45° field of view. Color fundus photograph. 2048 x 1536 pixels.
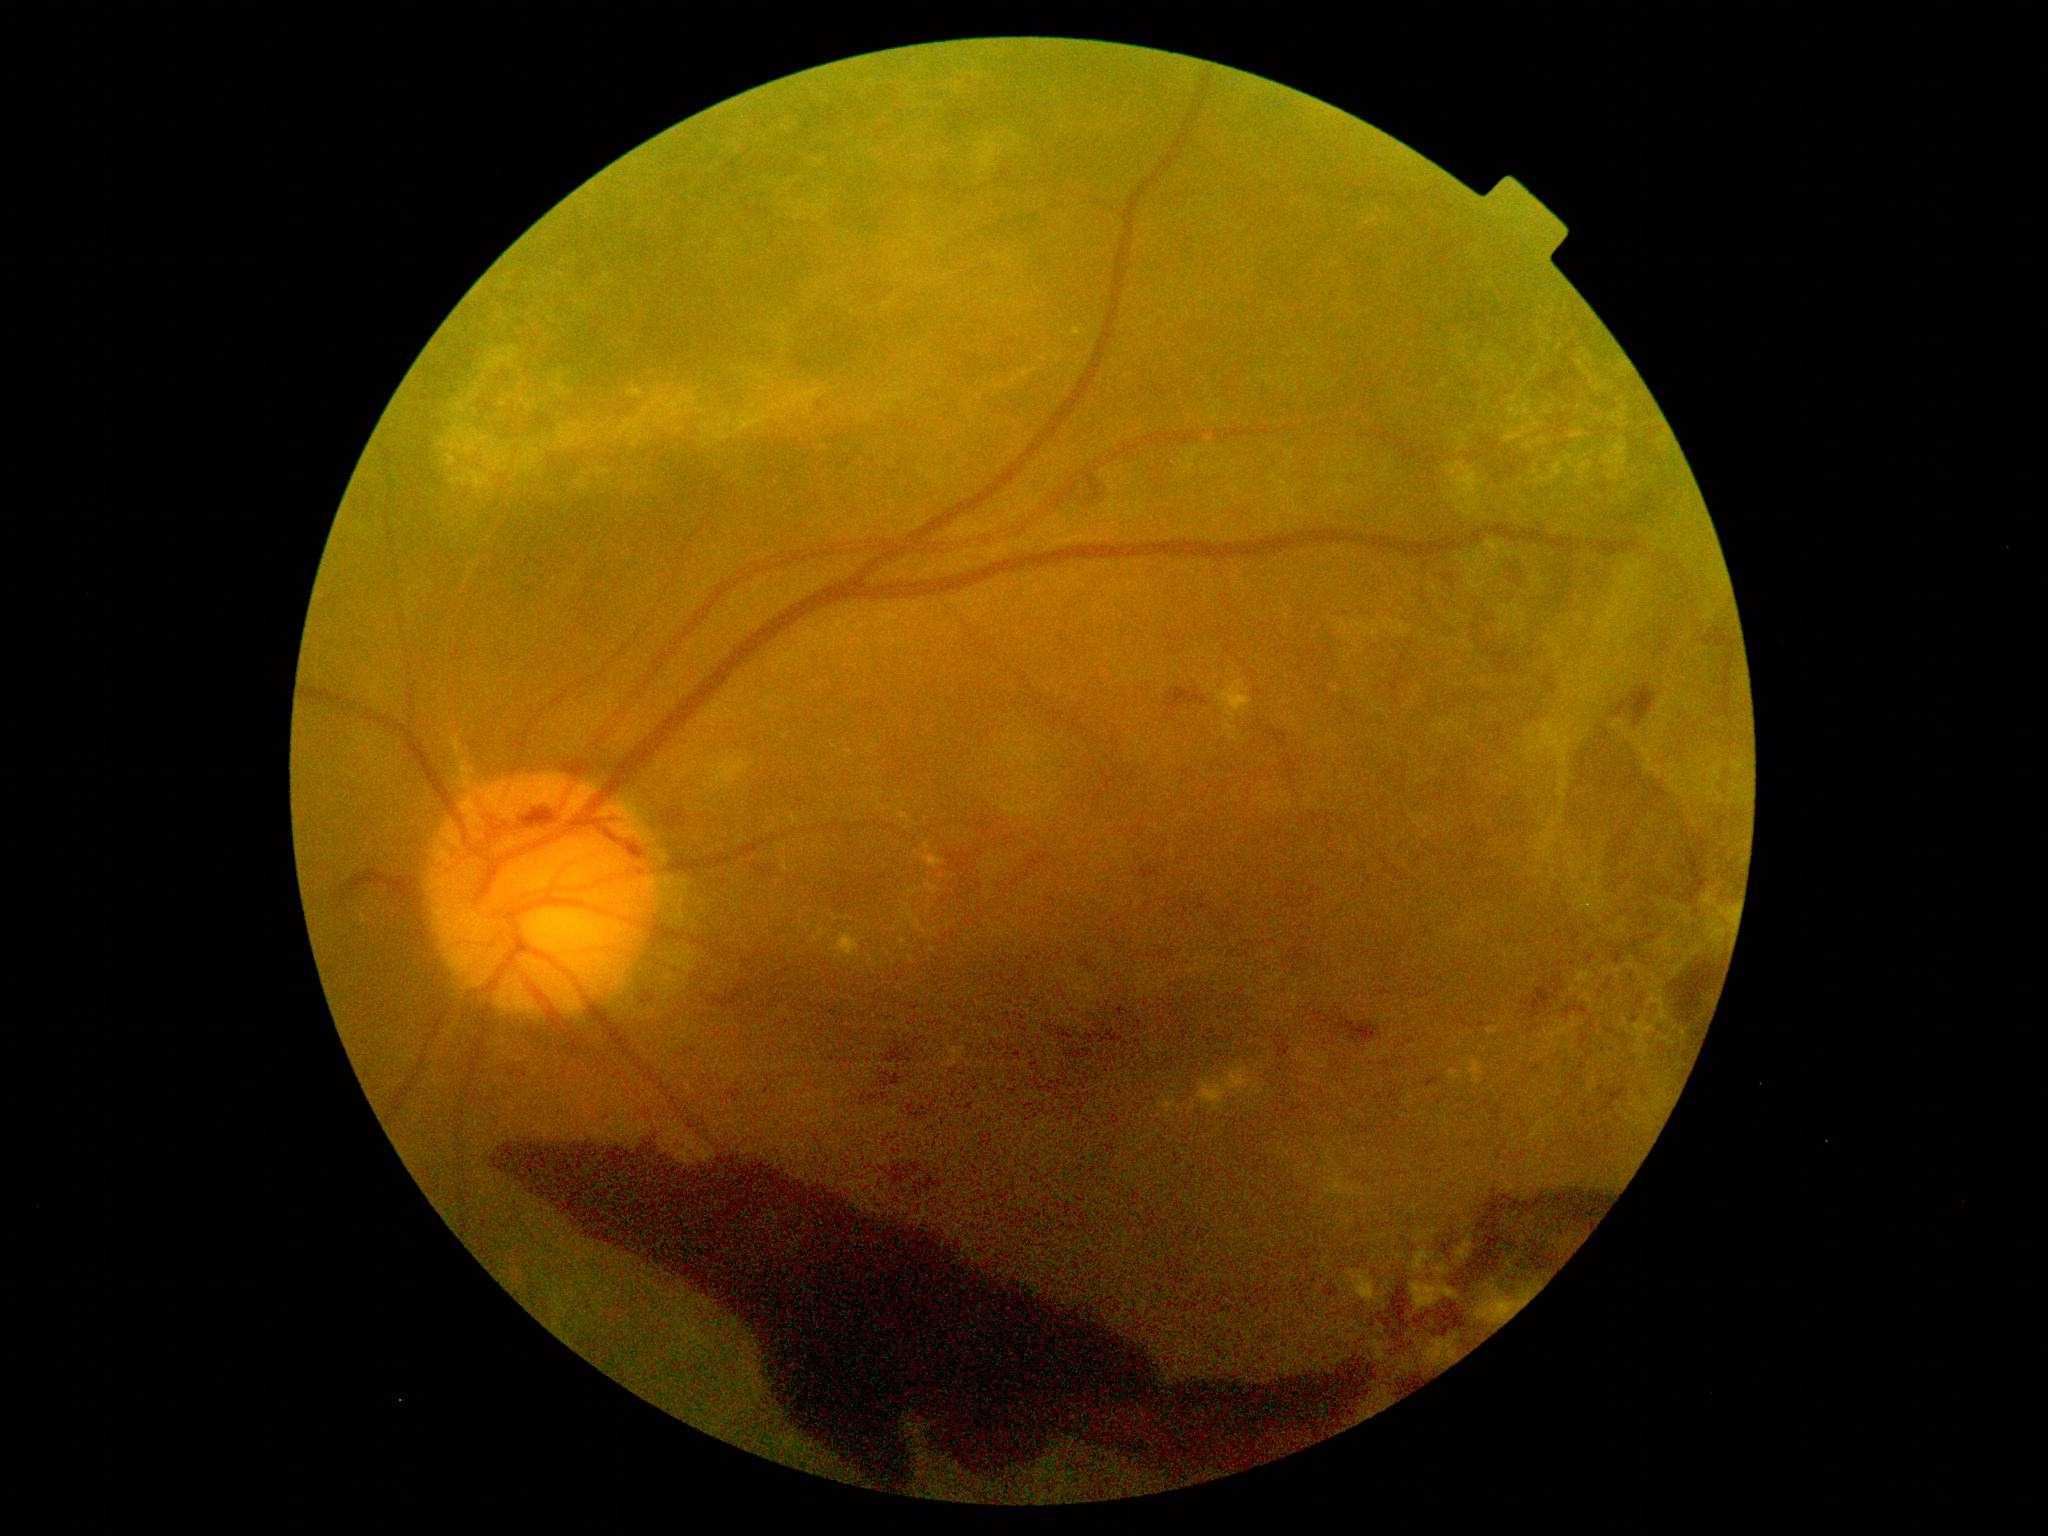 DR grade is 4 (PDR).